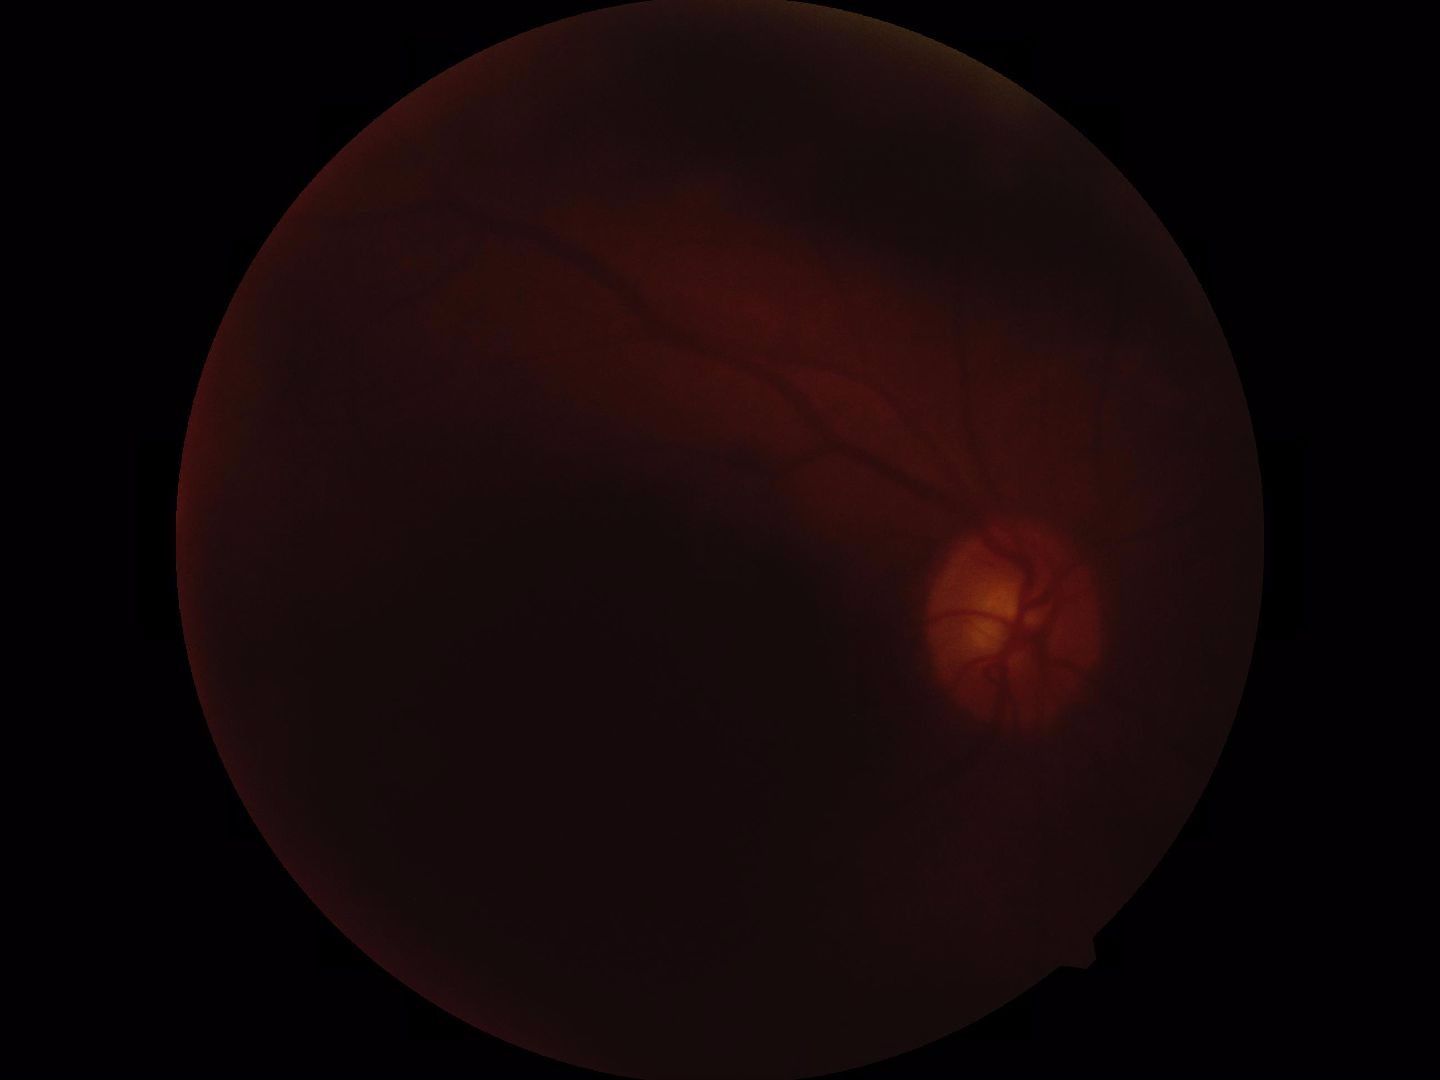
Quality: poor, substantial obscuration of retinal landmarks. Proliferative retinopathy: no evidence.